Wide-field contact fundus photograph of an infant:
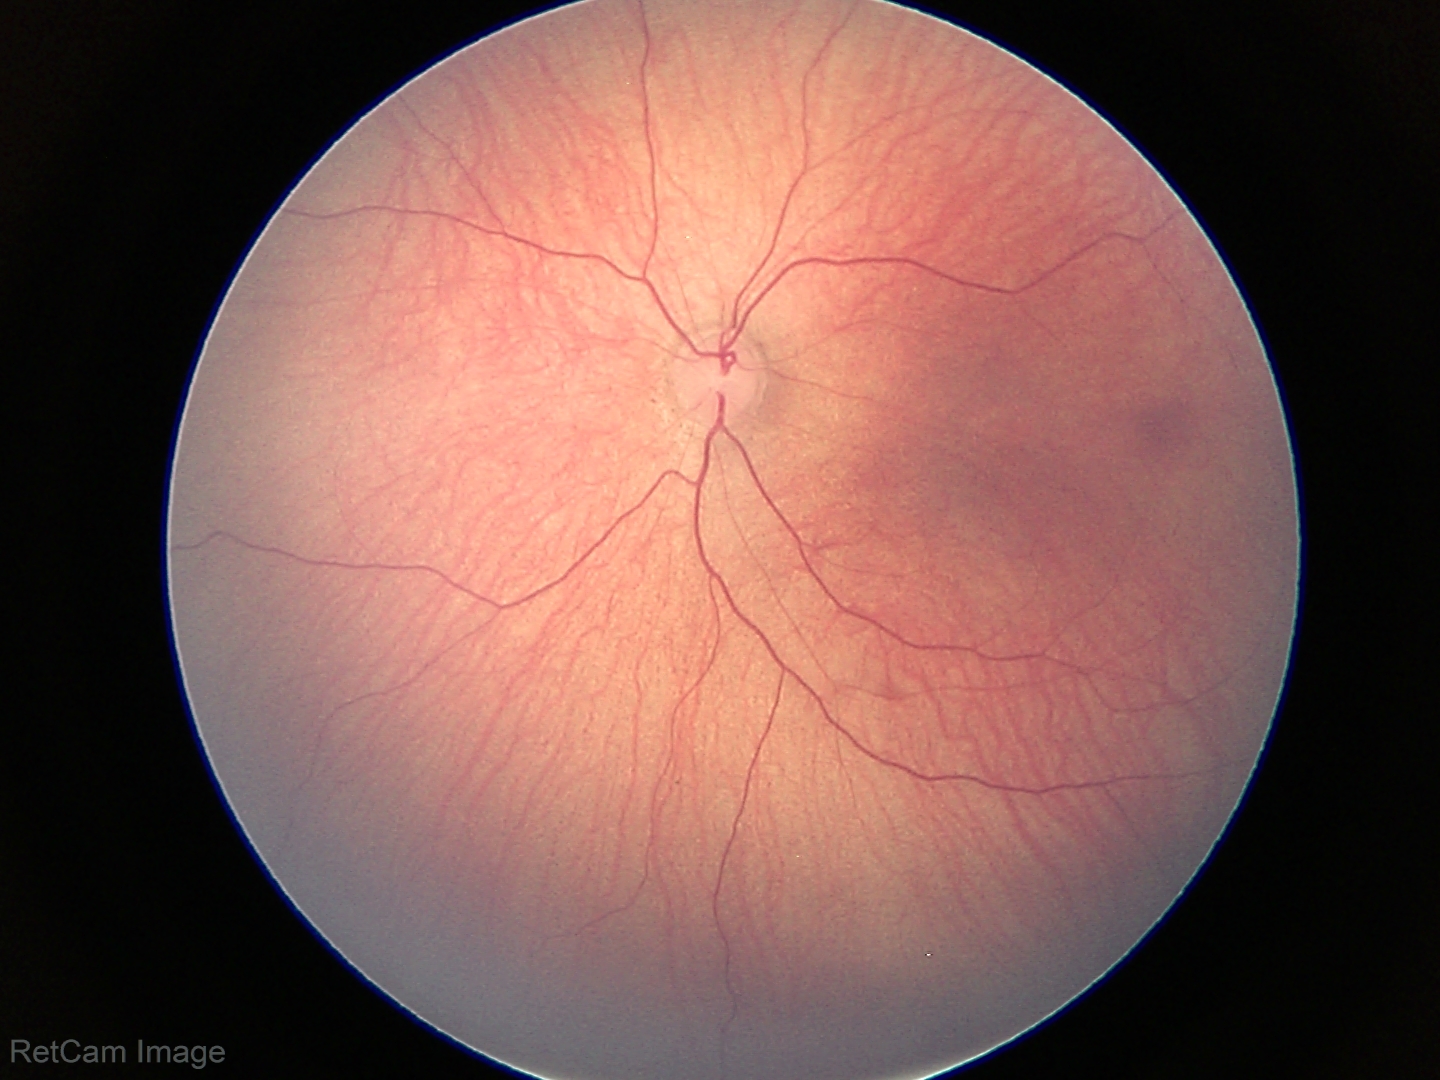
Normal screening examination.